848 x 848 pixels. Posterior pole photograph:
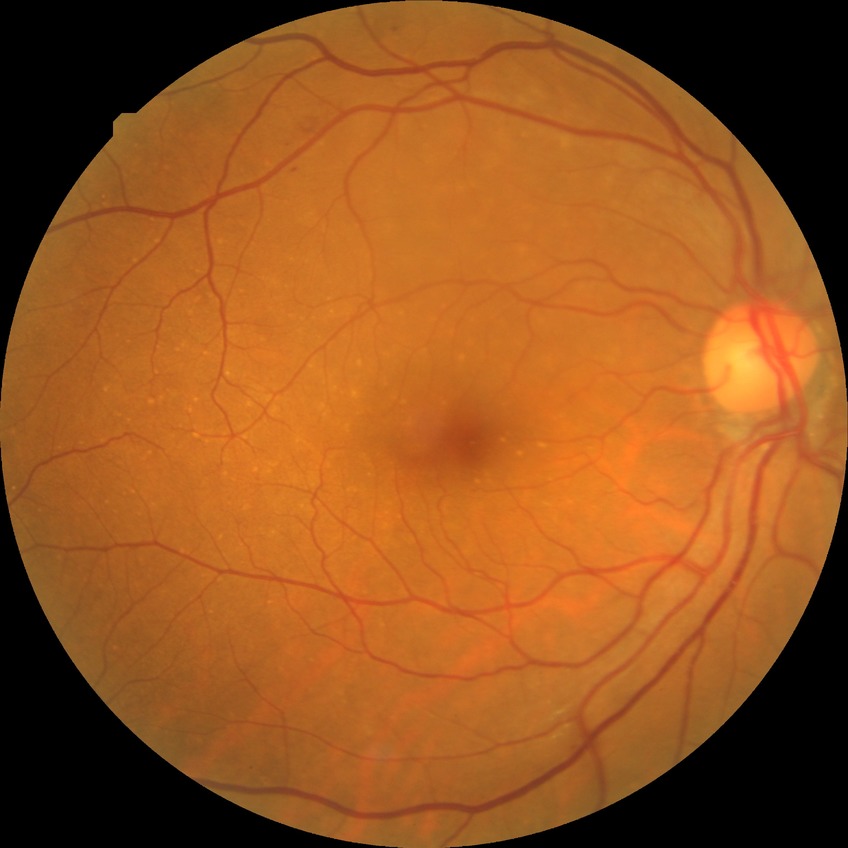 DR class = non-proliferative diabetic retinopathy; diabetic retinopathy (DR) = SDR (simple diabetic retinopathy).